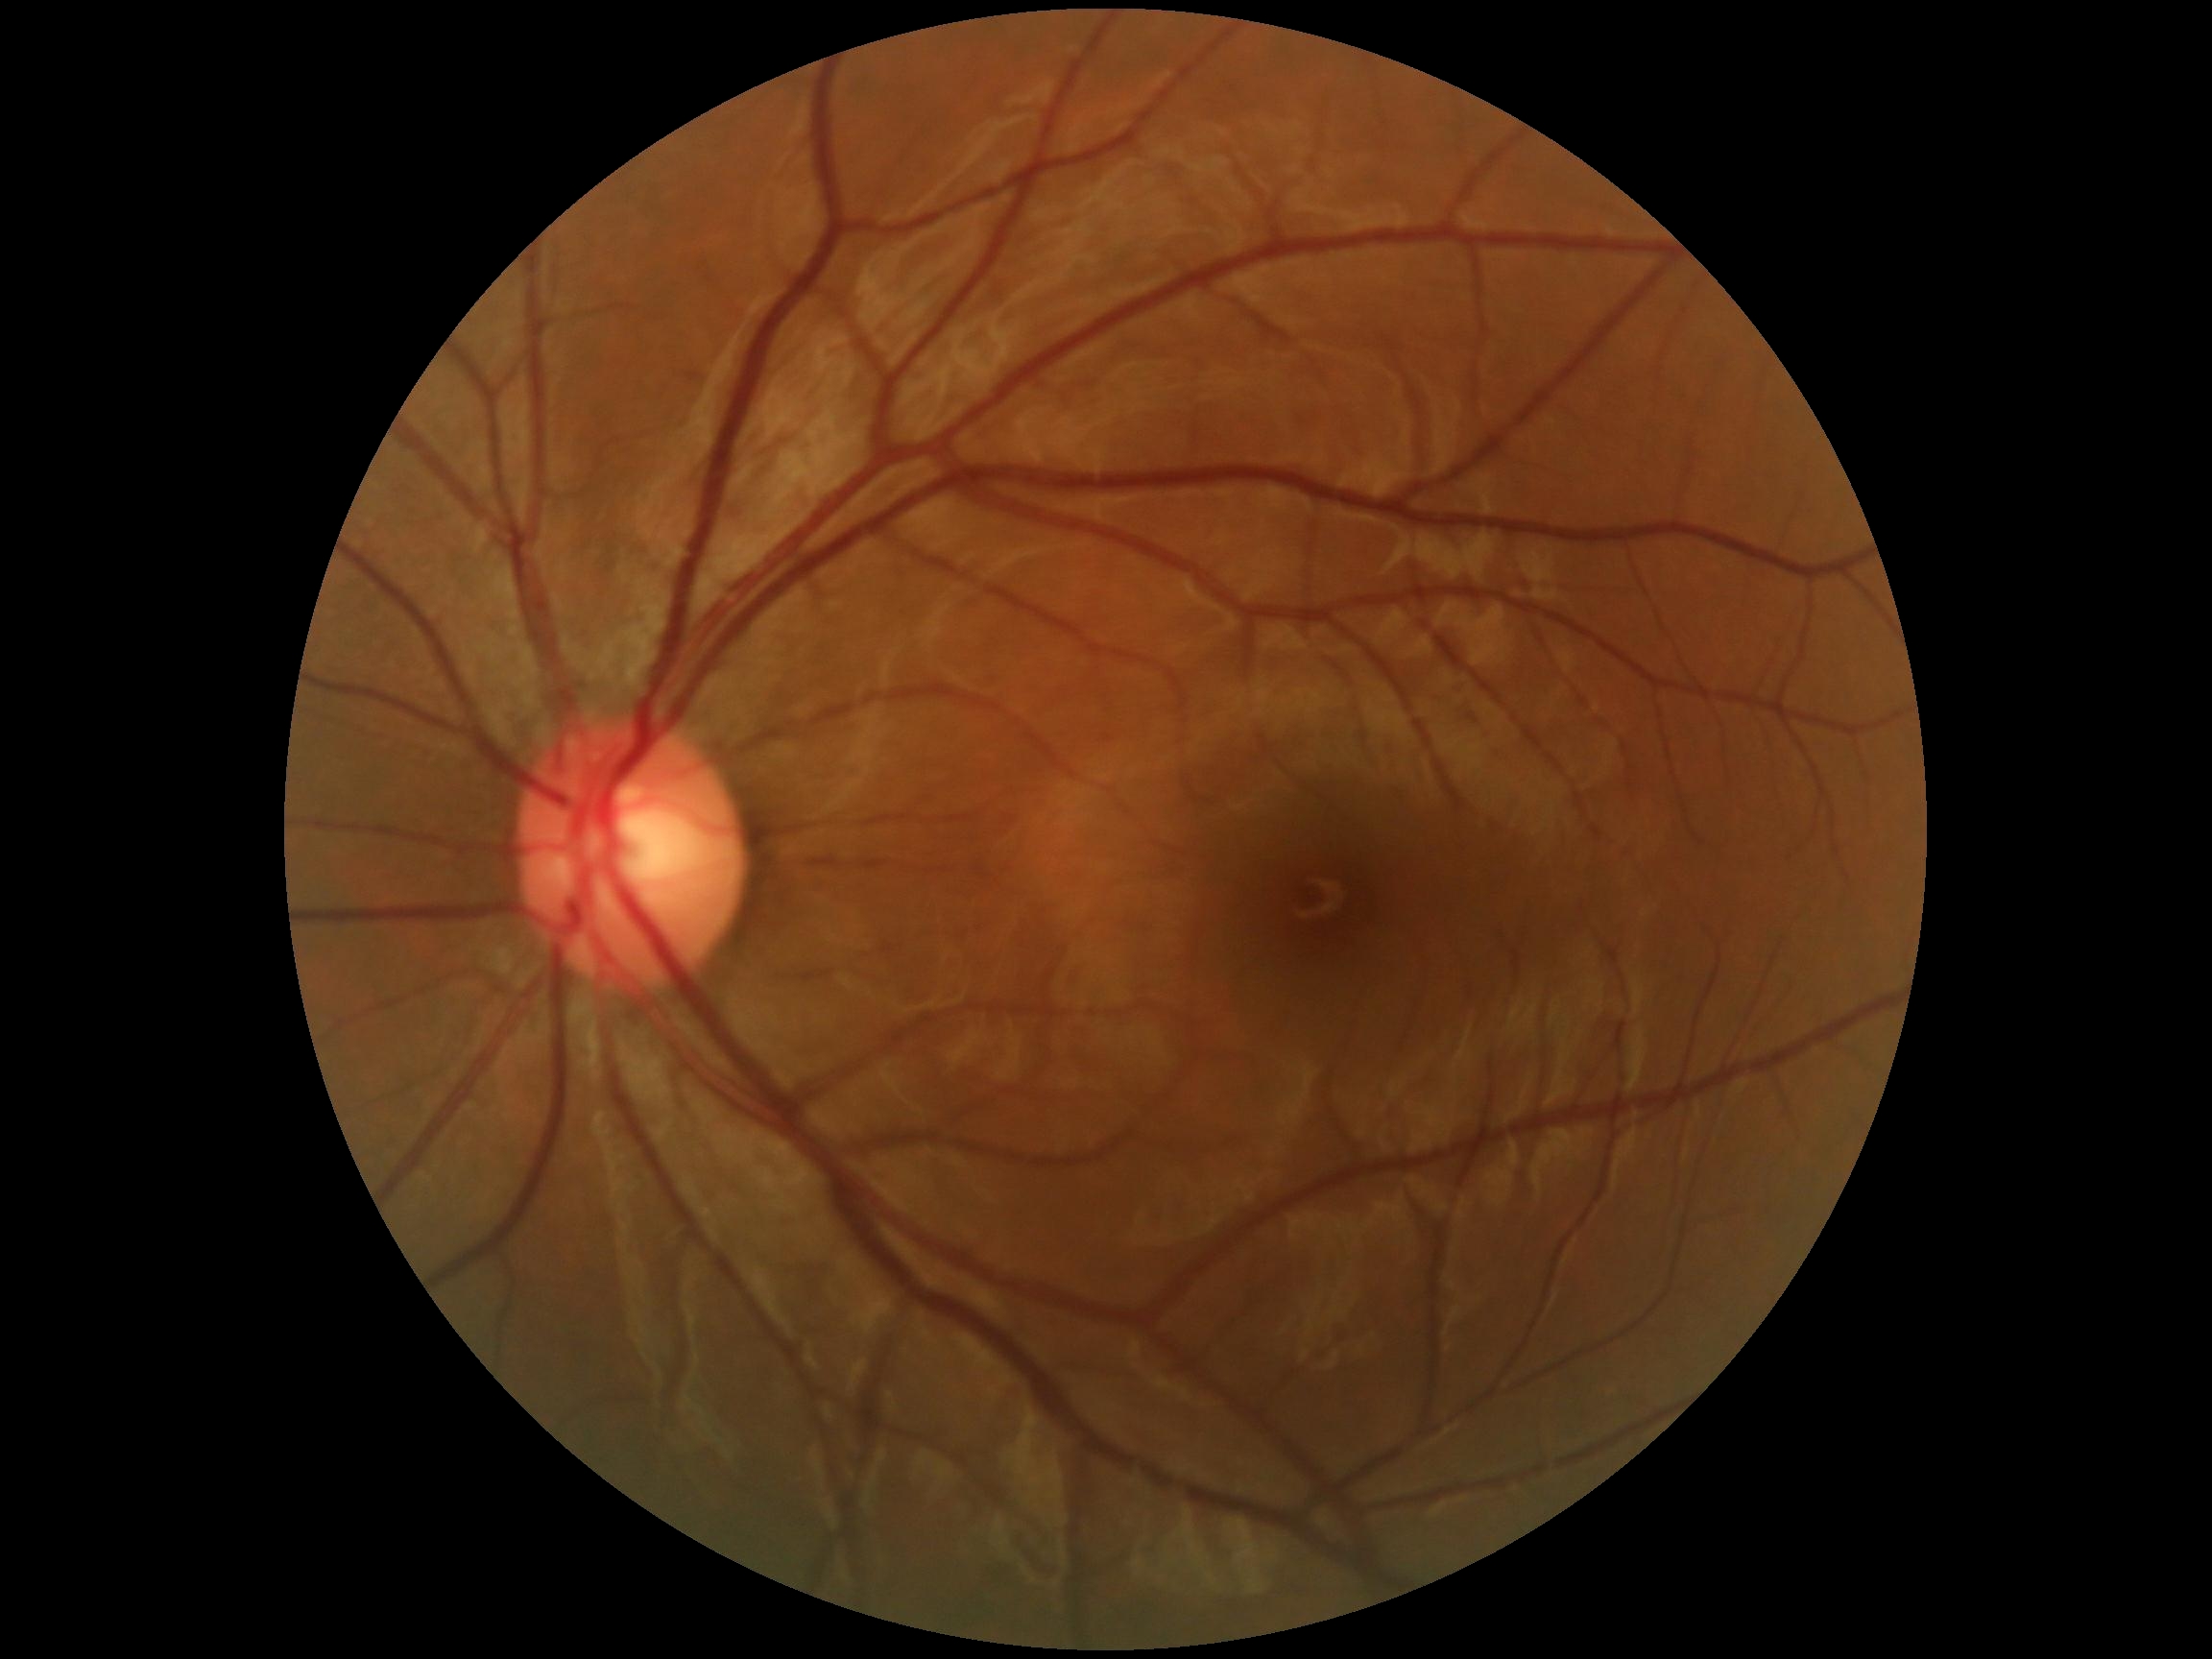

DR severity@0/4.